45° FOV · nonmydriatic · posterior pole color fundus photograph — 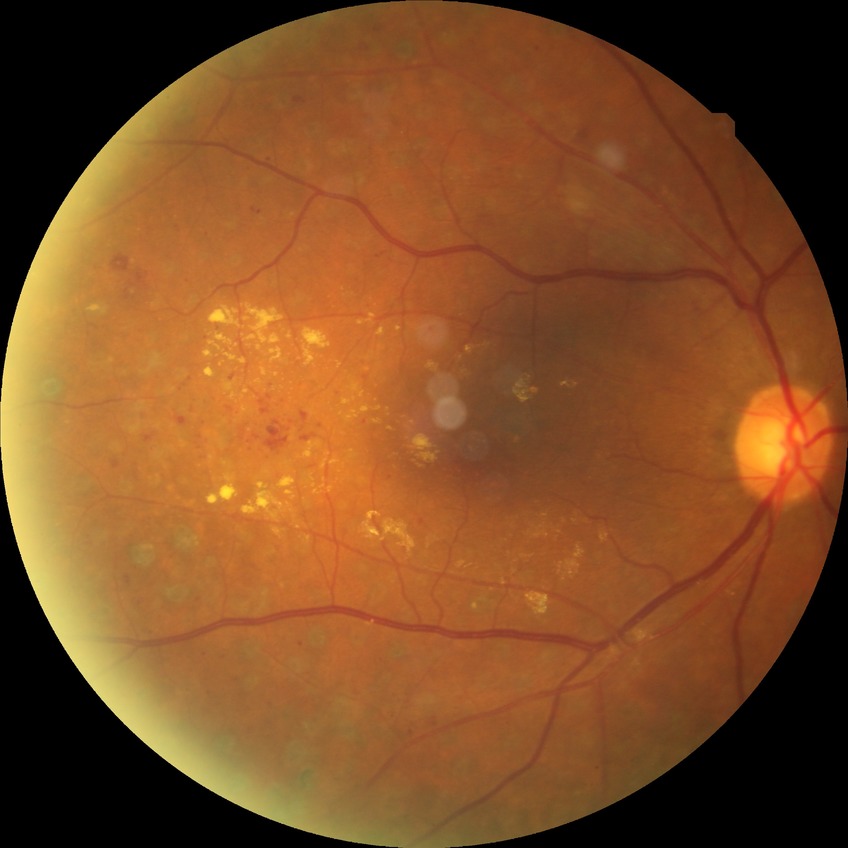 Annotations:
• diabetic retinopathy (DR) — proliferative diabetic retinopathy (PDR)